50° FOV · central posterior field — 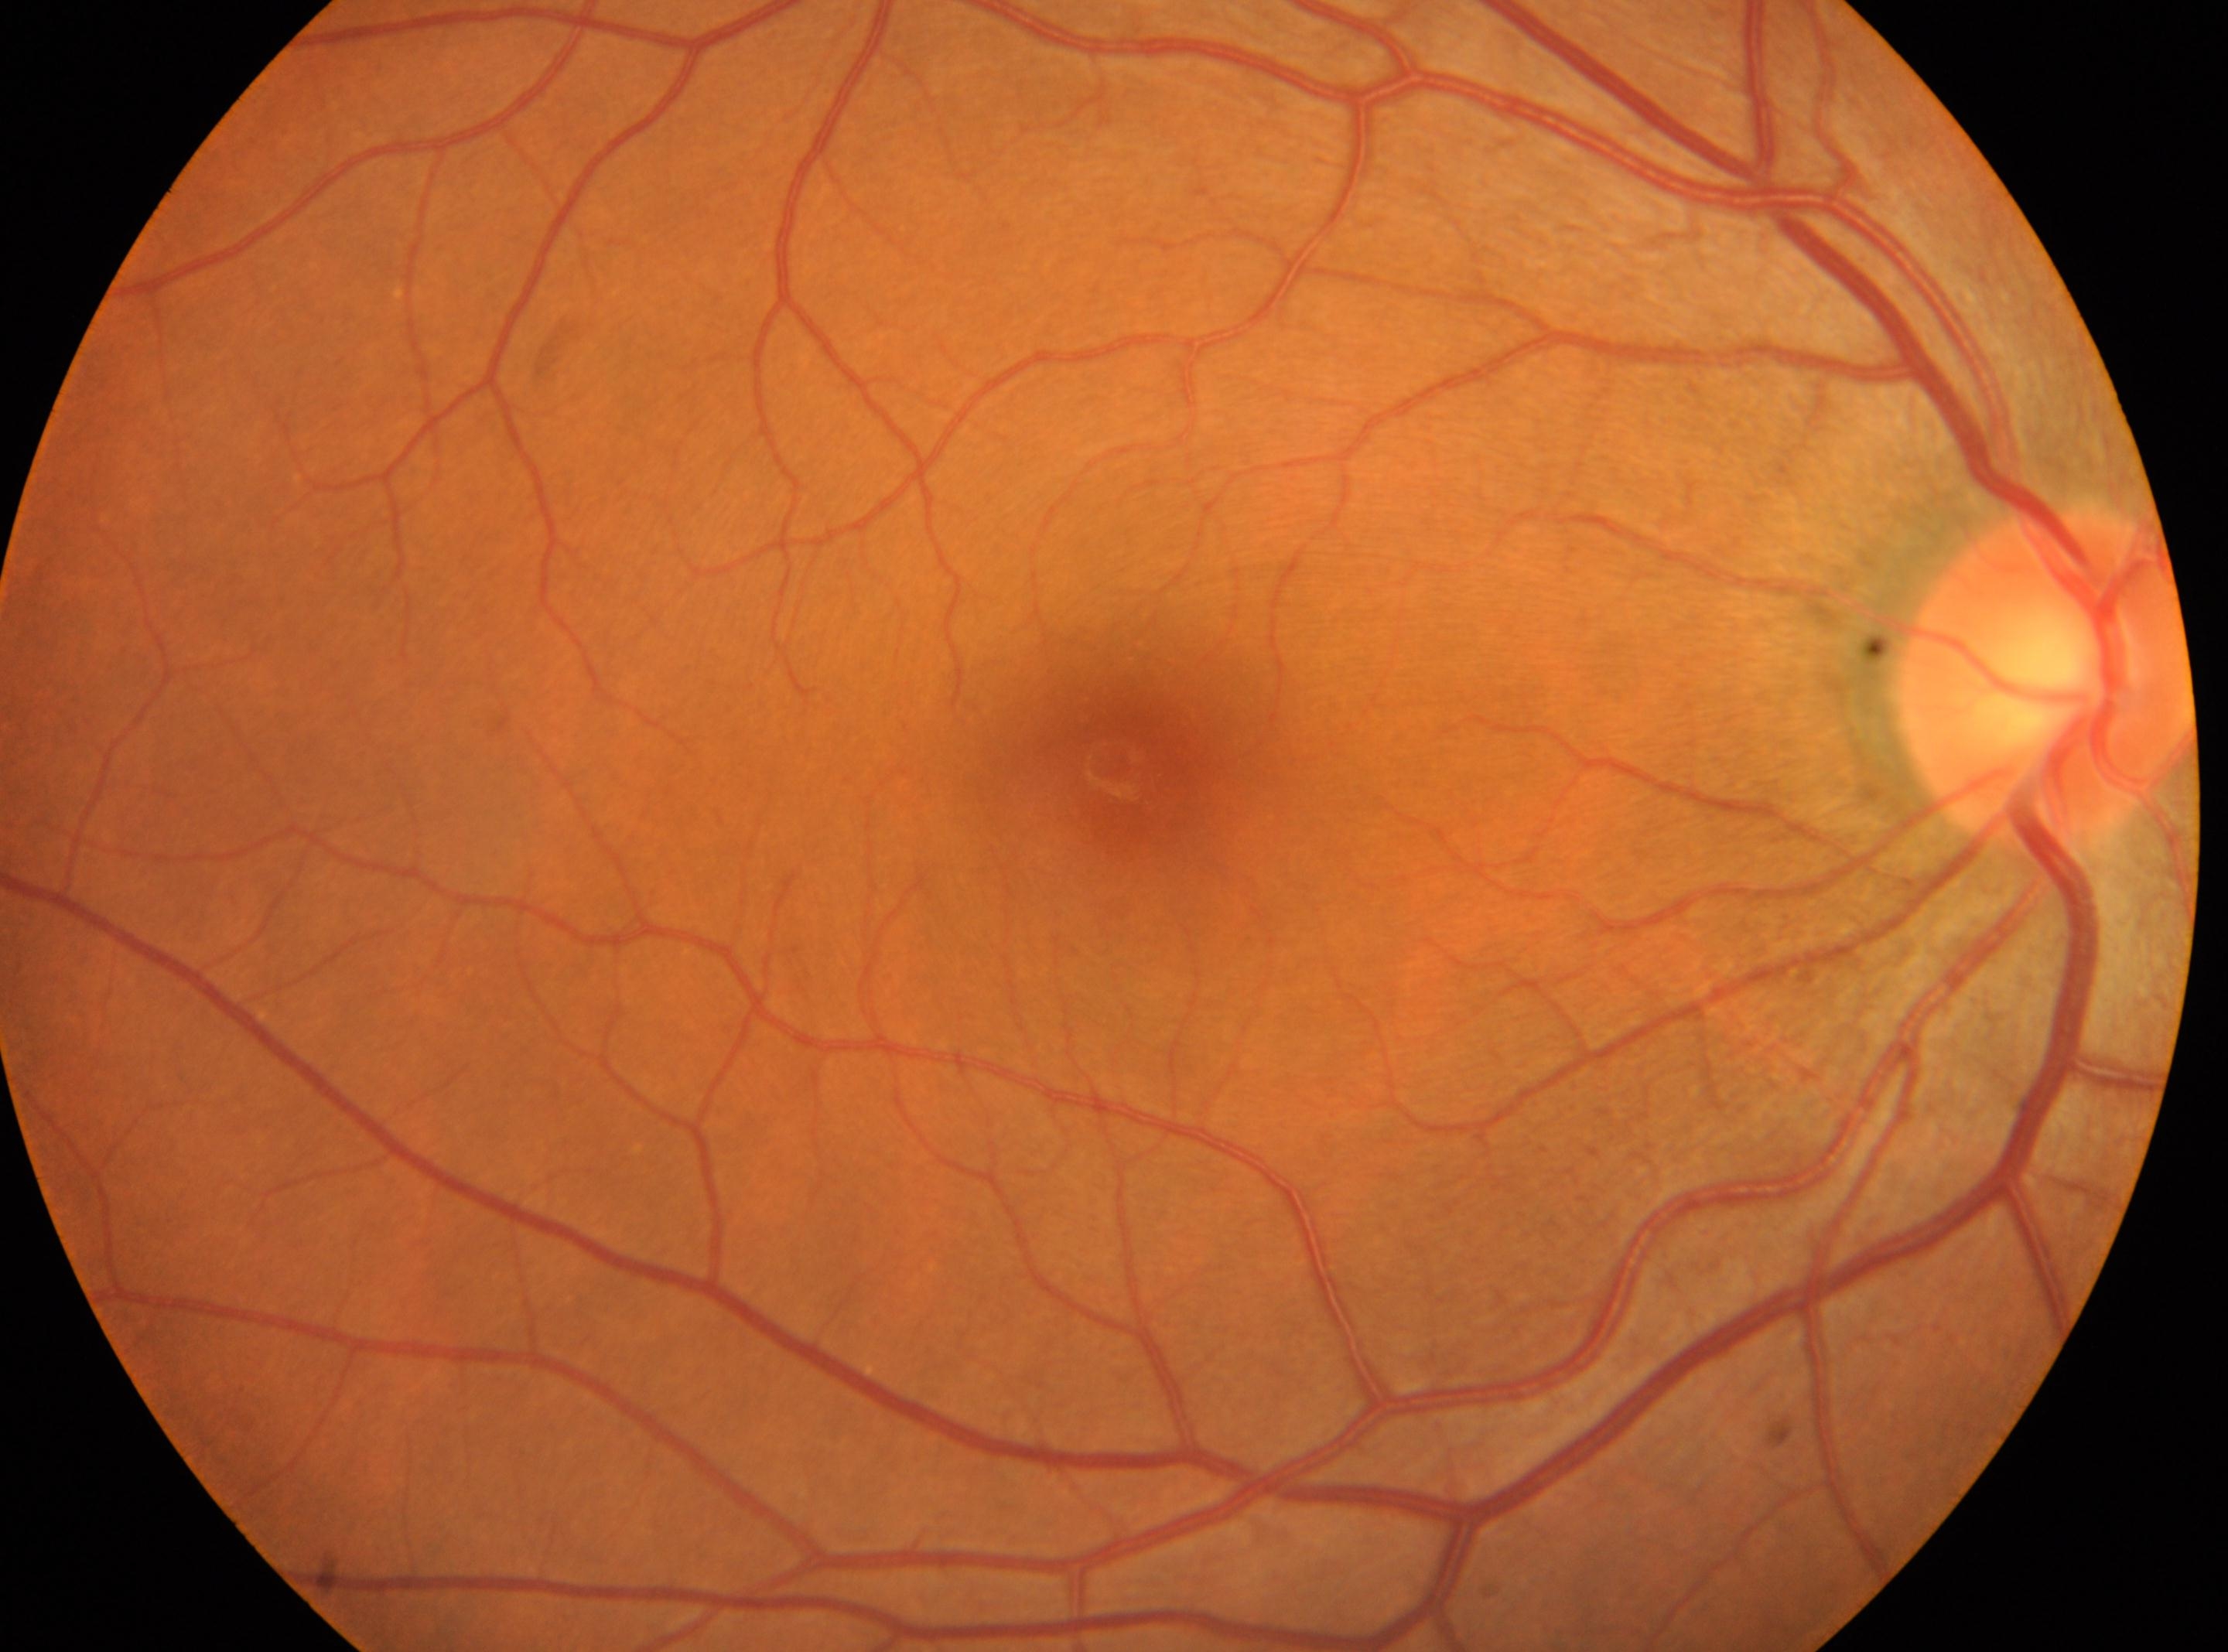 The optic disc is at x=2044, y=681. DR severity: no apparent retinopathy (grade 0) — no visible signs of diabetic retinopathy. Fovea: x=1111, y=764. Eye: right eye. No apparent diabetic retinopathy.